640 x 480 pixels · RetCam wide-field infant fundus image:
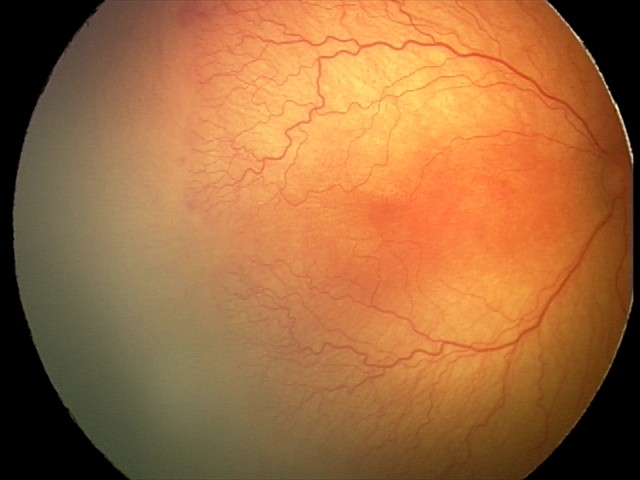
Impression: plus disease; aggressive retinopathy of prematurity (A-ROP).